Ultra-widefield (UWF) fundus image:
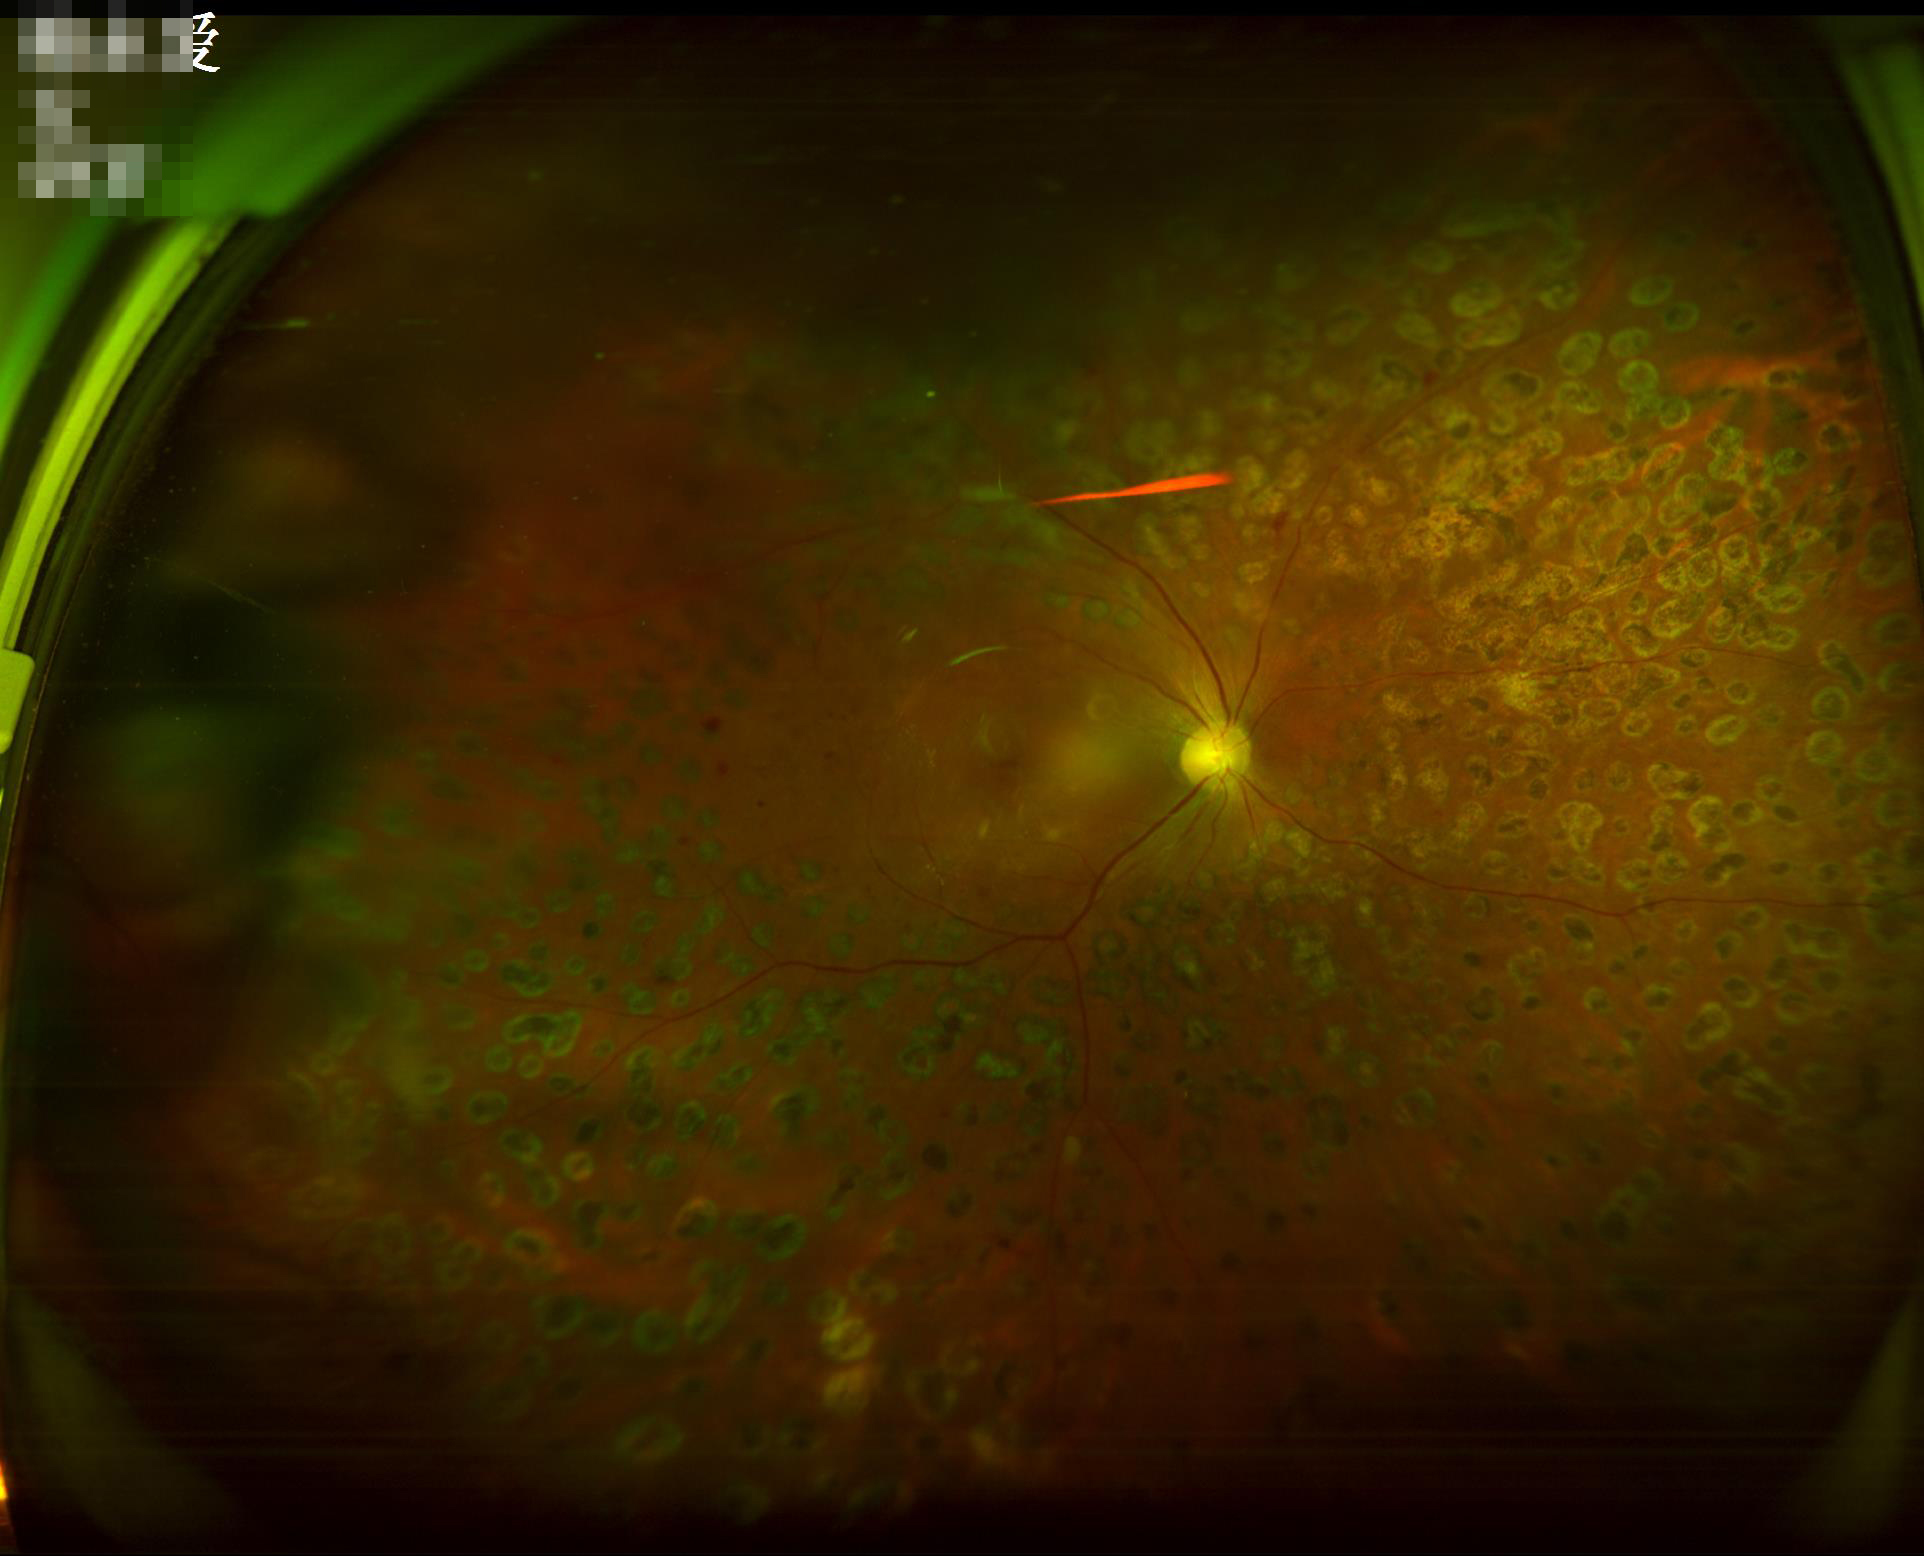
Image quality: contrast: vessels and details readily distinguishable | clarity: out of focus, structures indistinct | overall: poor, ungradable | illumination/color: uneven illumination or color cast.